2352x1568. Color fundus image. 45° field of view
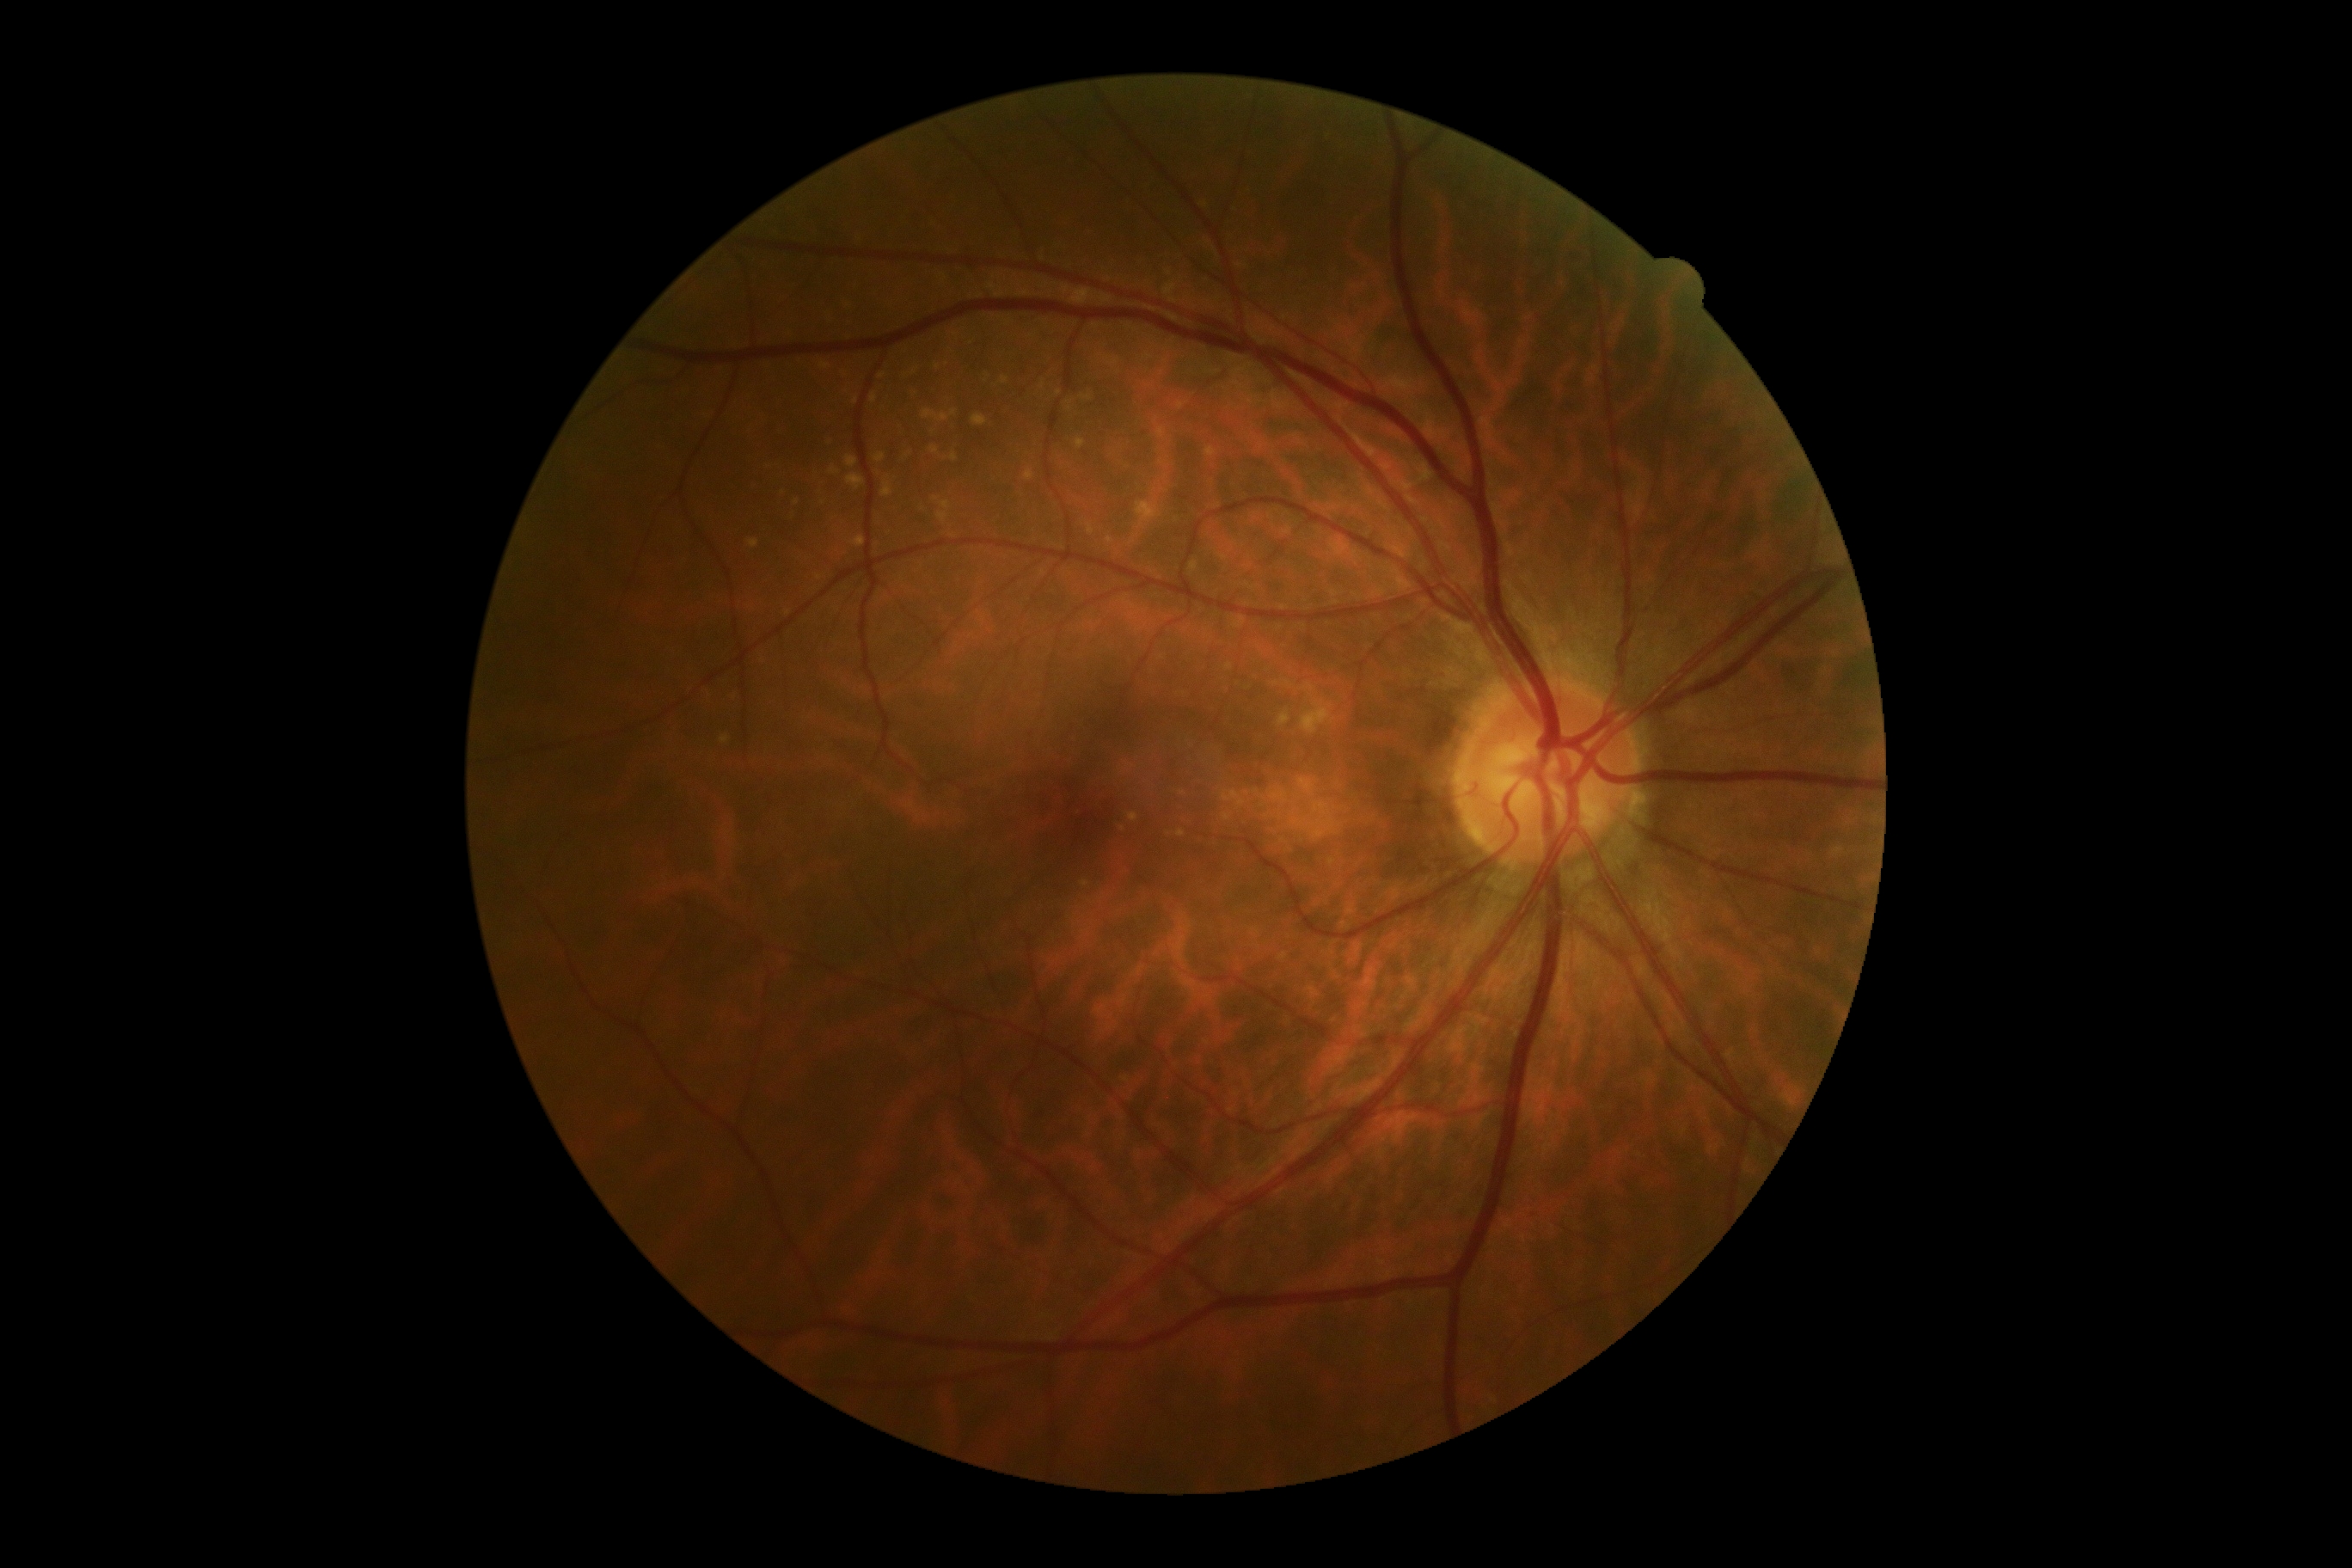

Annotations:
• DR stage — 0 — no visible signs of diabetic retinopathy